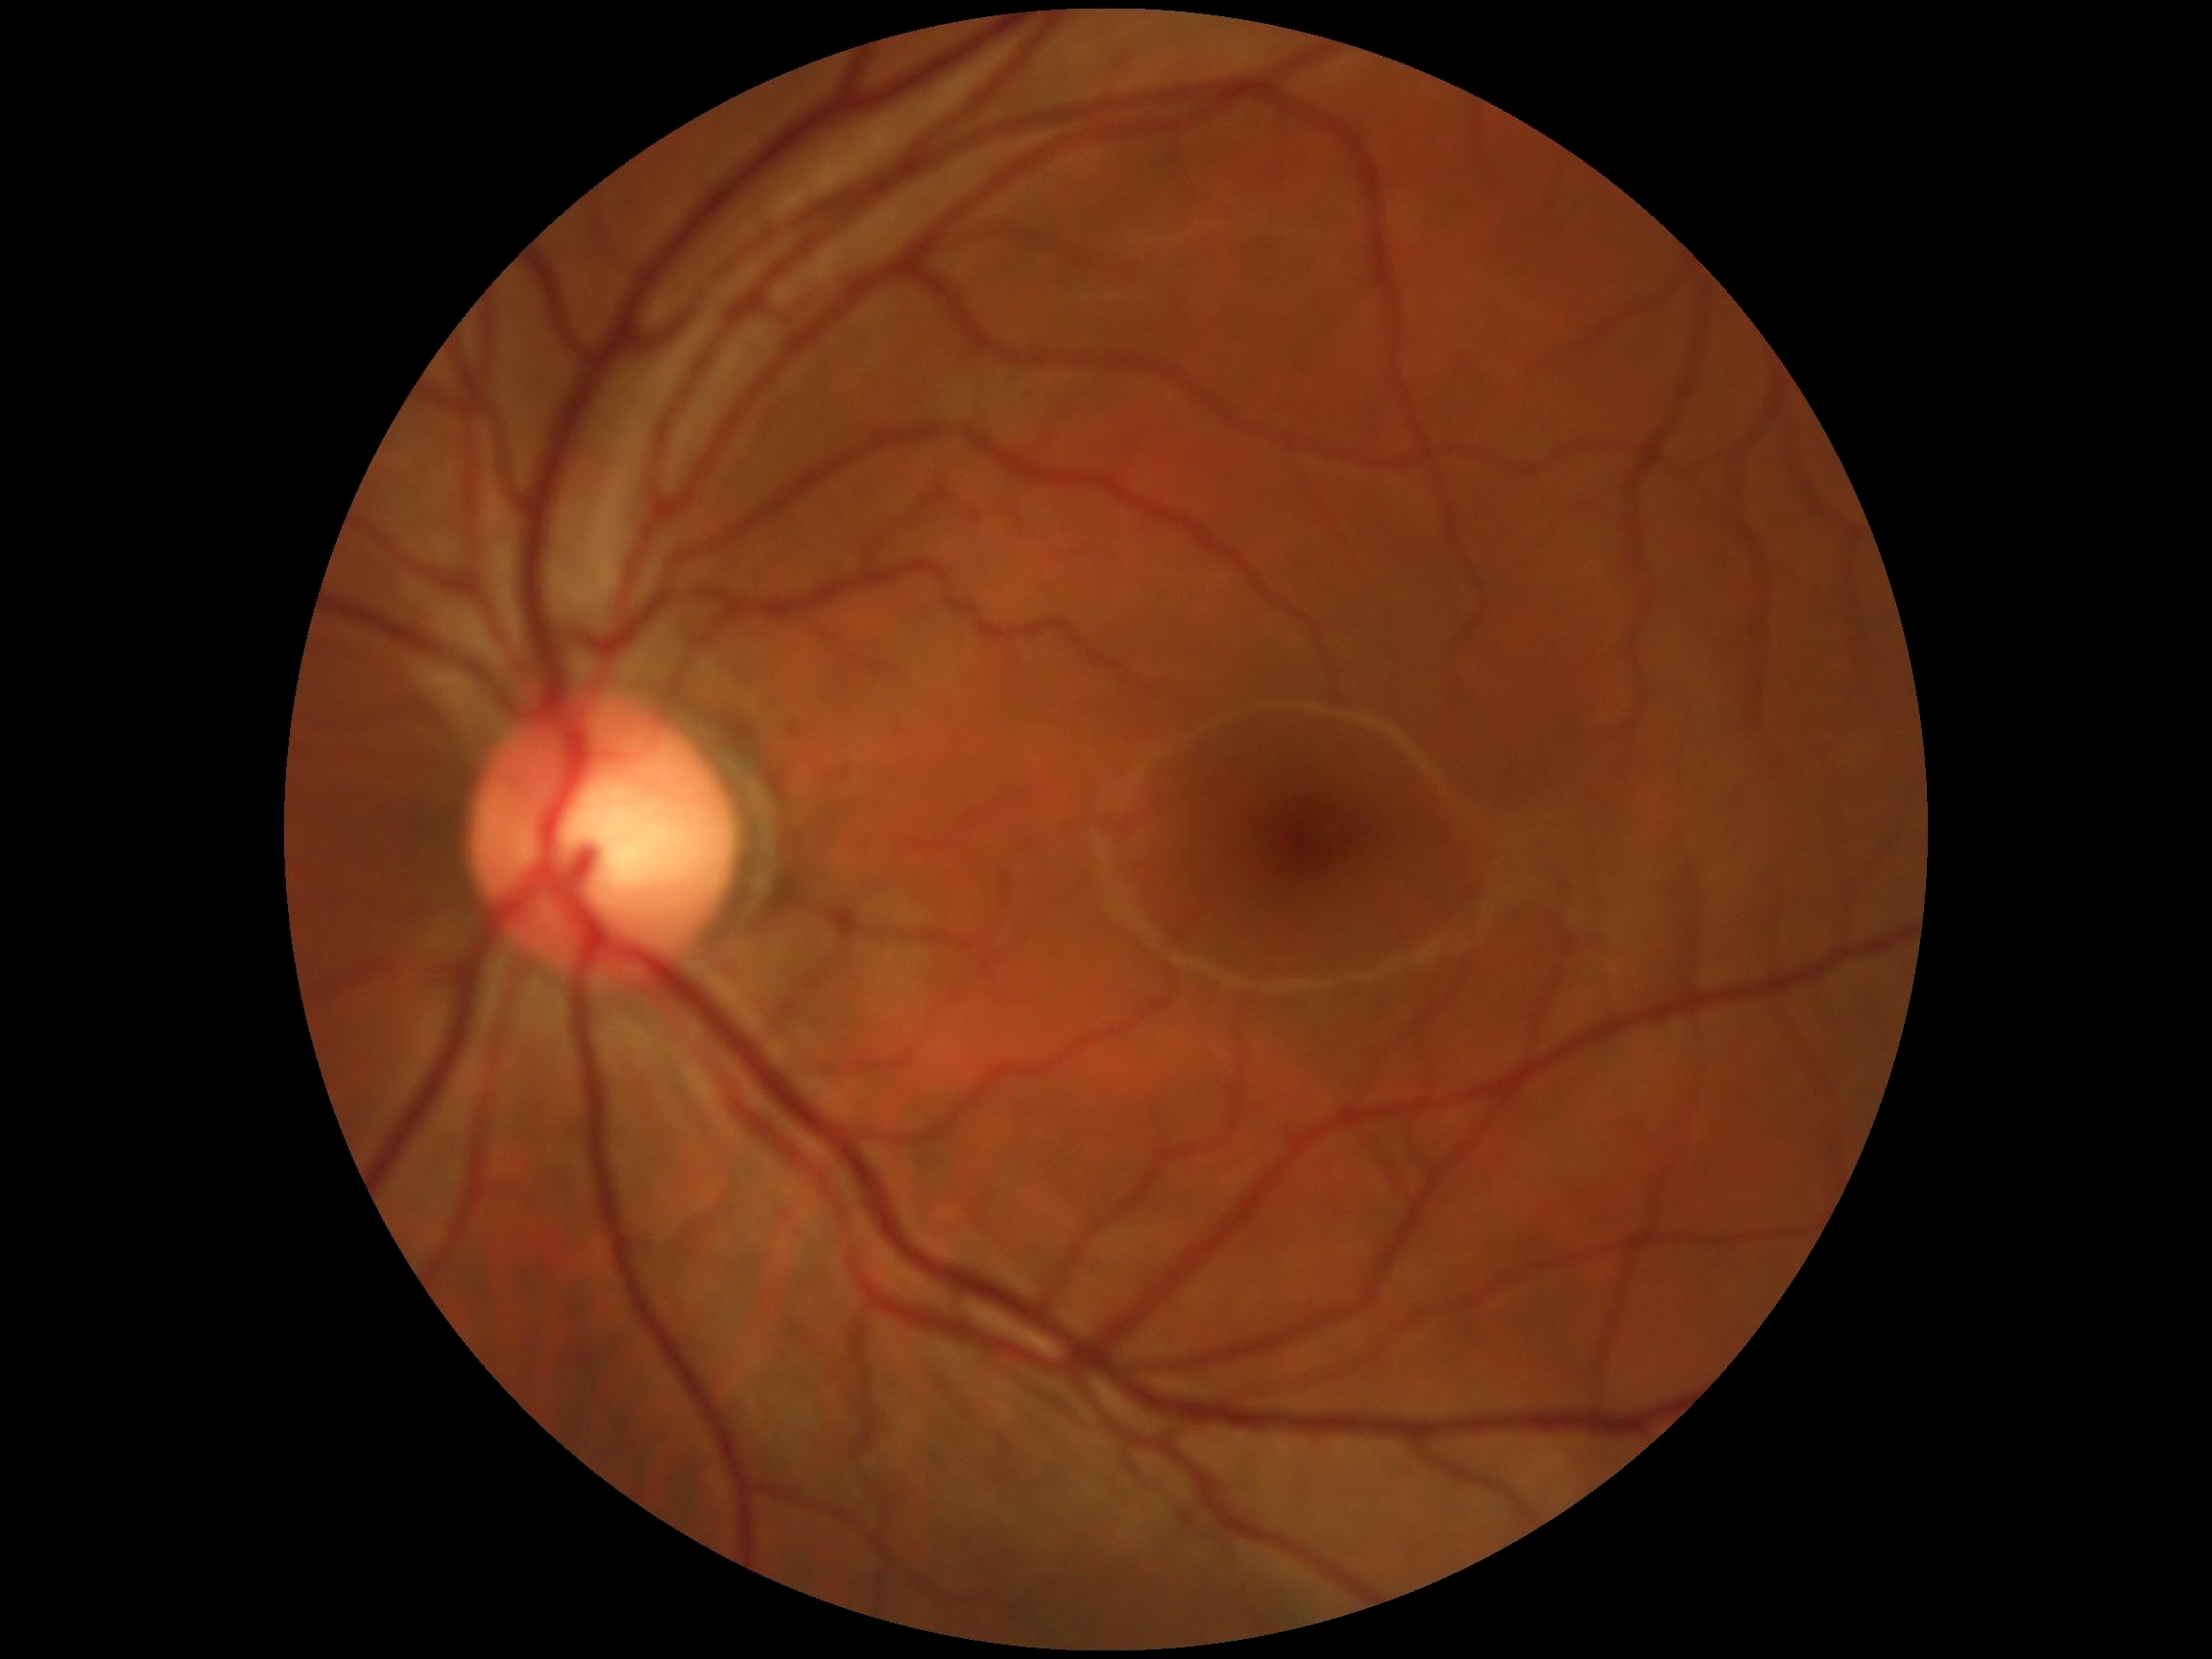
Annotations:
* DR — grade 0 (no apparent retinopathy)